No pharmacologic dilation, DR severity per modified Davis staging: 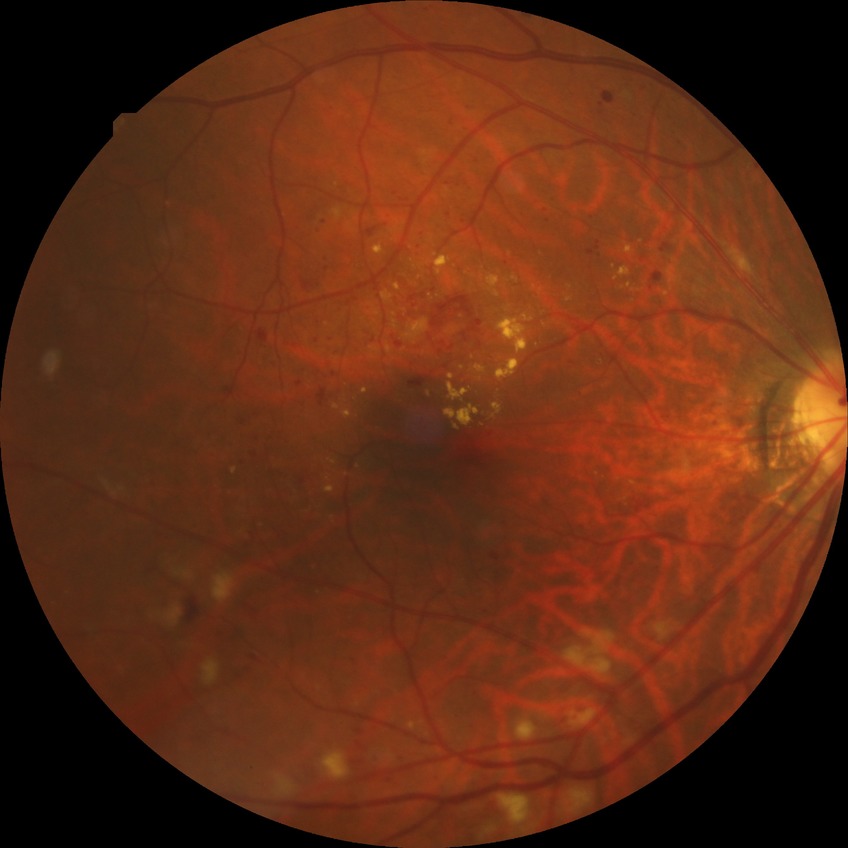 diabetic retinopathy stage@pre-proliferative diabetic retinopathy.